Infant wide-field fundus photograph: 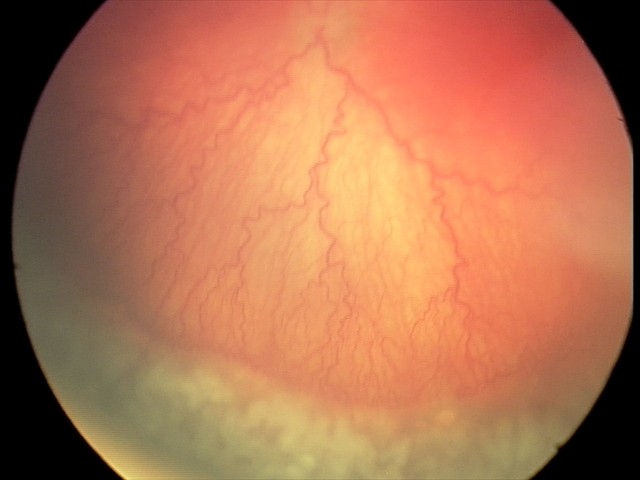
Series diagnosed as aggressive ROP (A-ROP).
Plus disease present.